Color fundus photograph, 45-degree field of view, image size 2352x1568 — 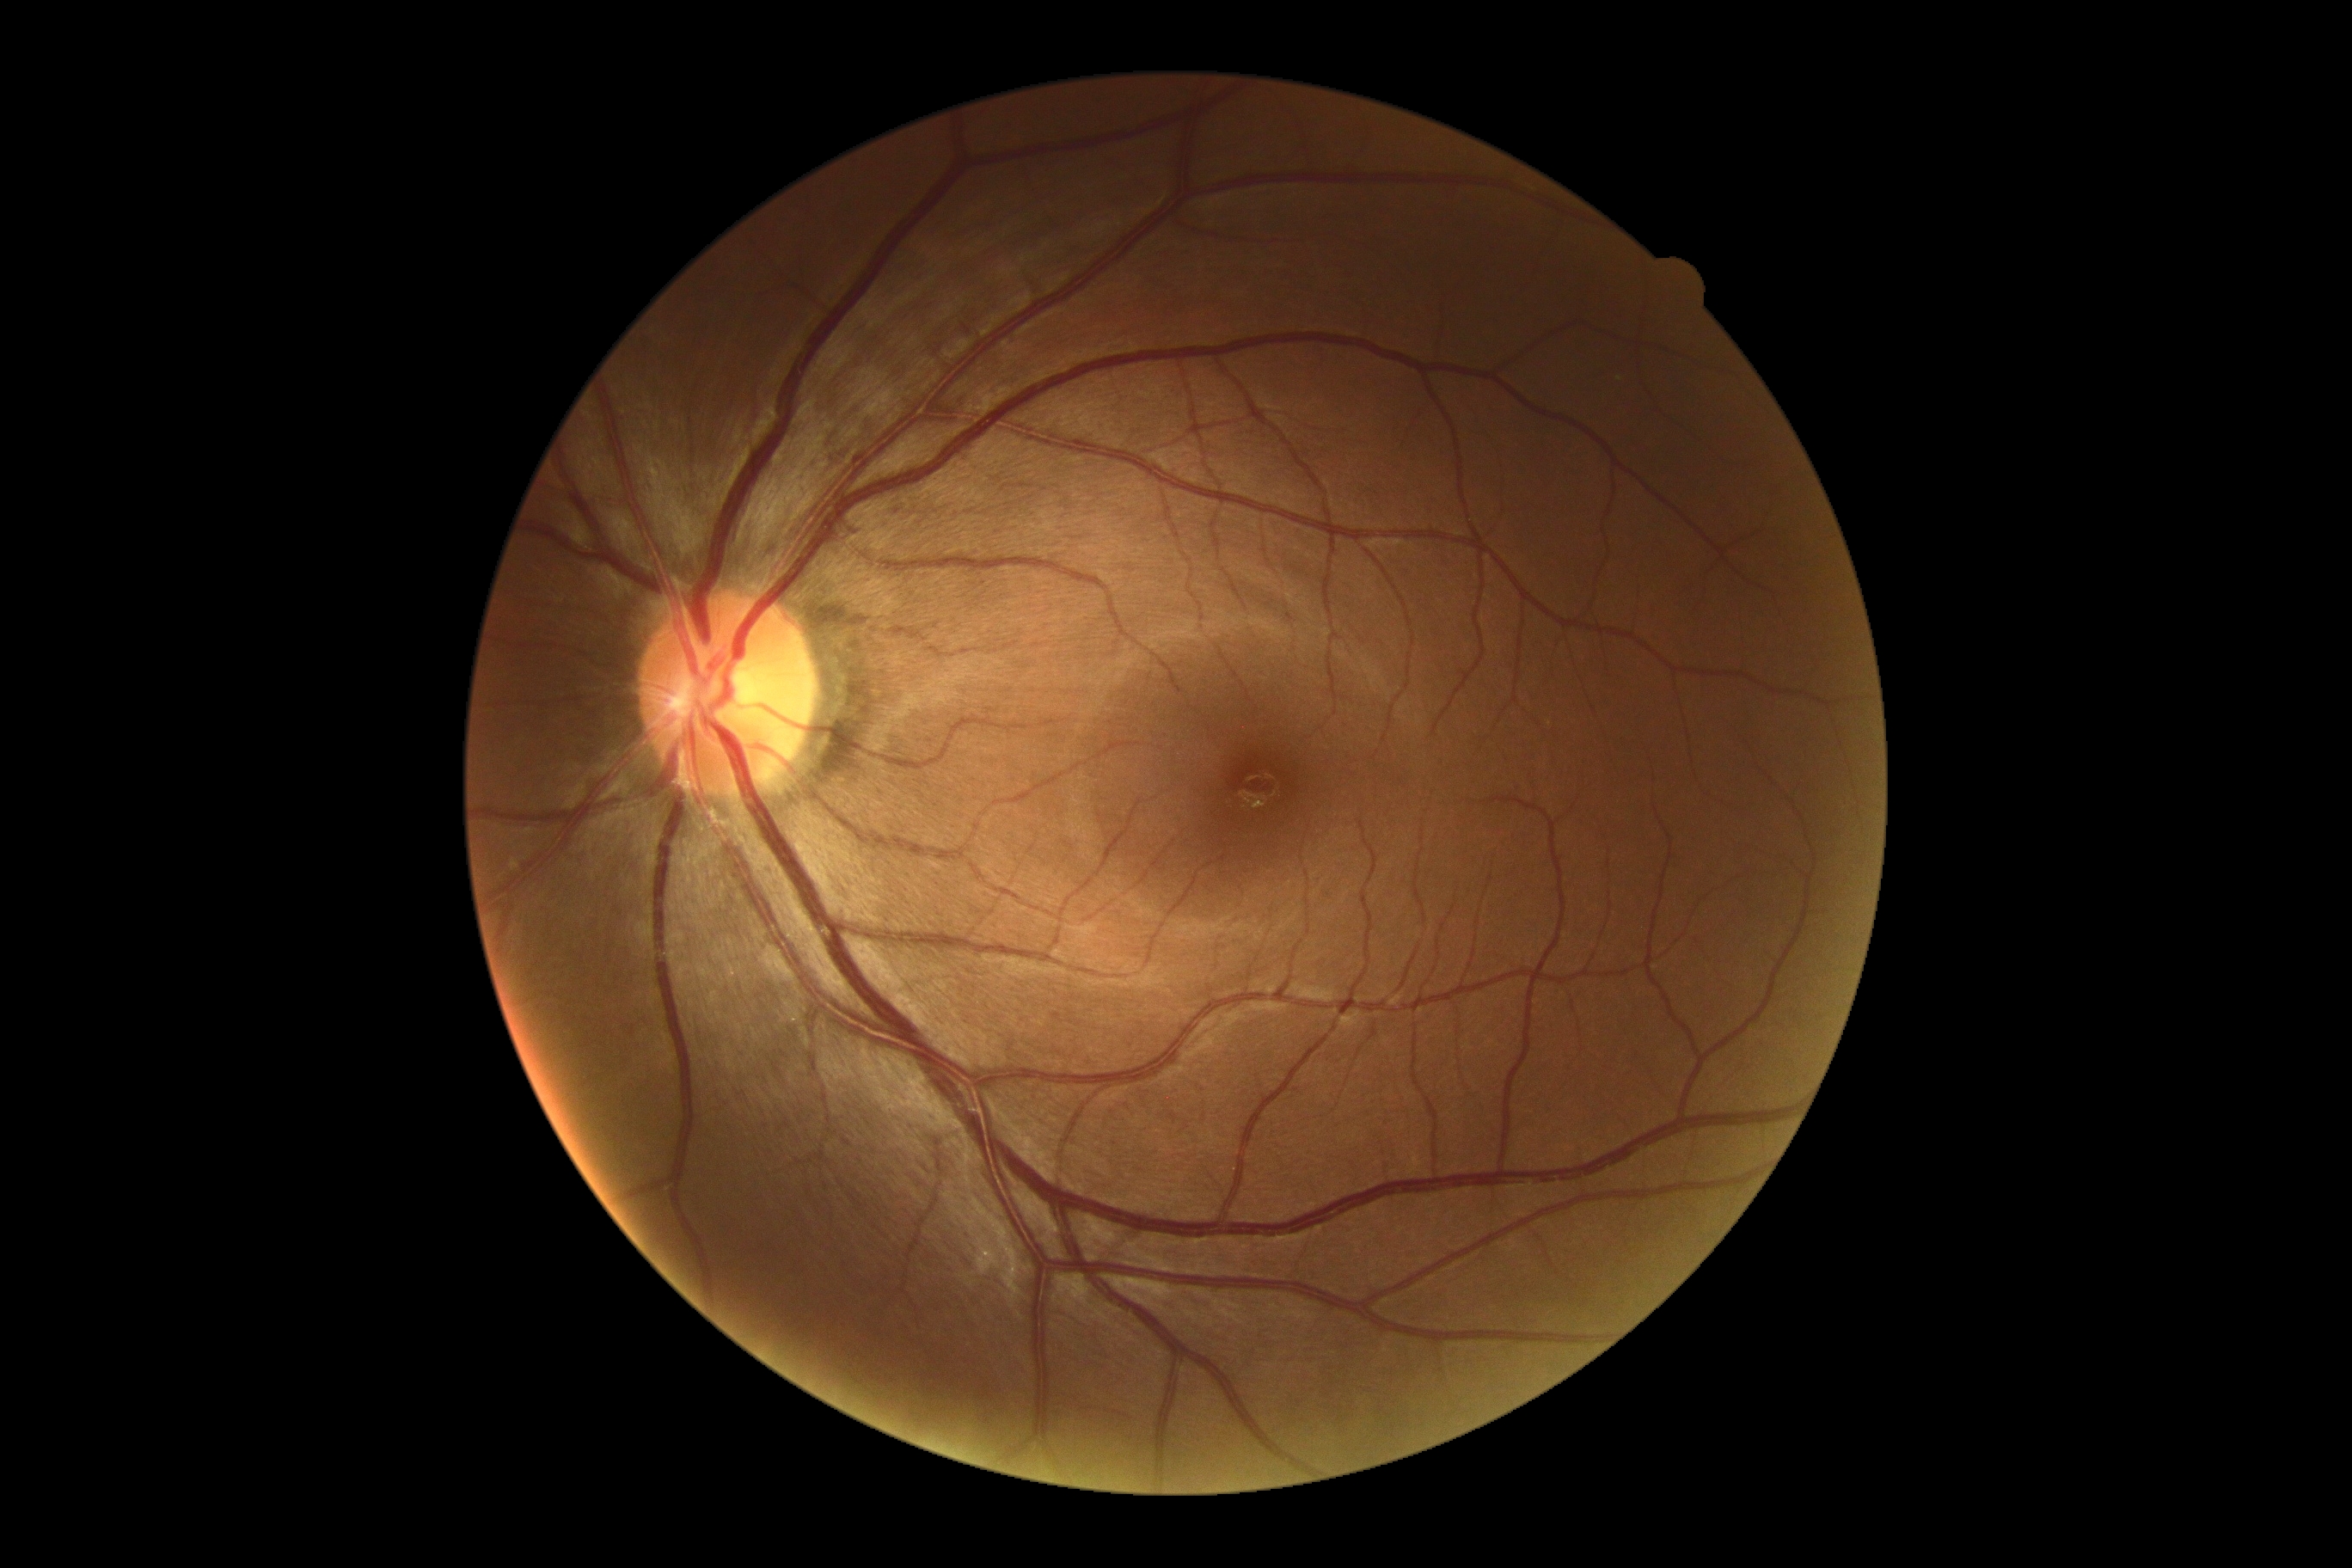

No DR findings.
DR stage is no apparent diabetic retinopathy (grade 0).